512 by 512 pixels · fundus photo
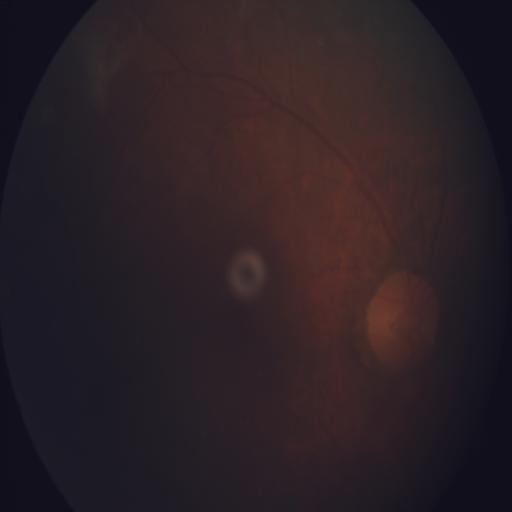

Diagnoses: media haze.